Pachymetry: 529 µm · axial length 22.27 mm · man patient · intraocular pressure 12 mmHg.
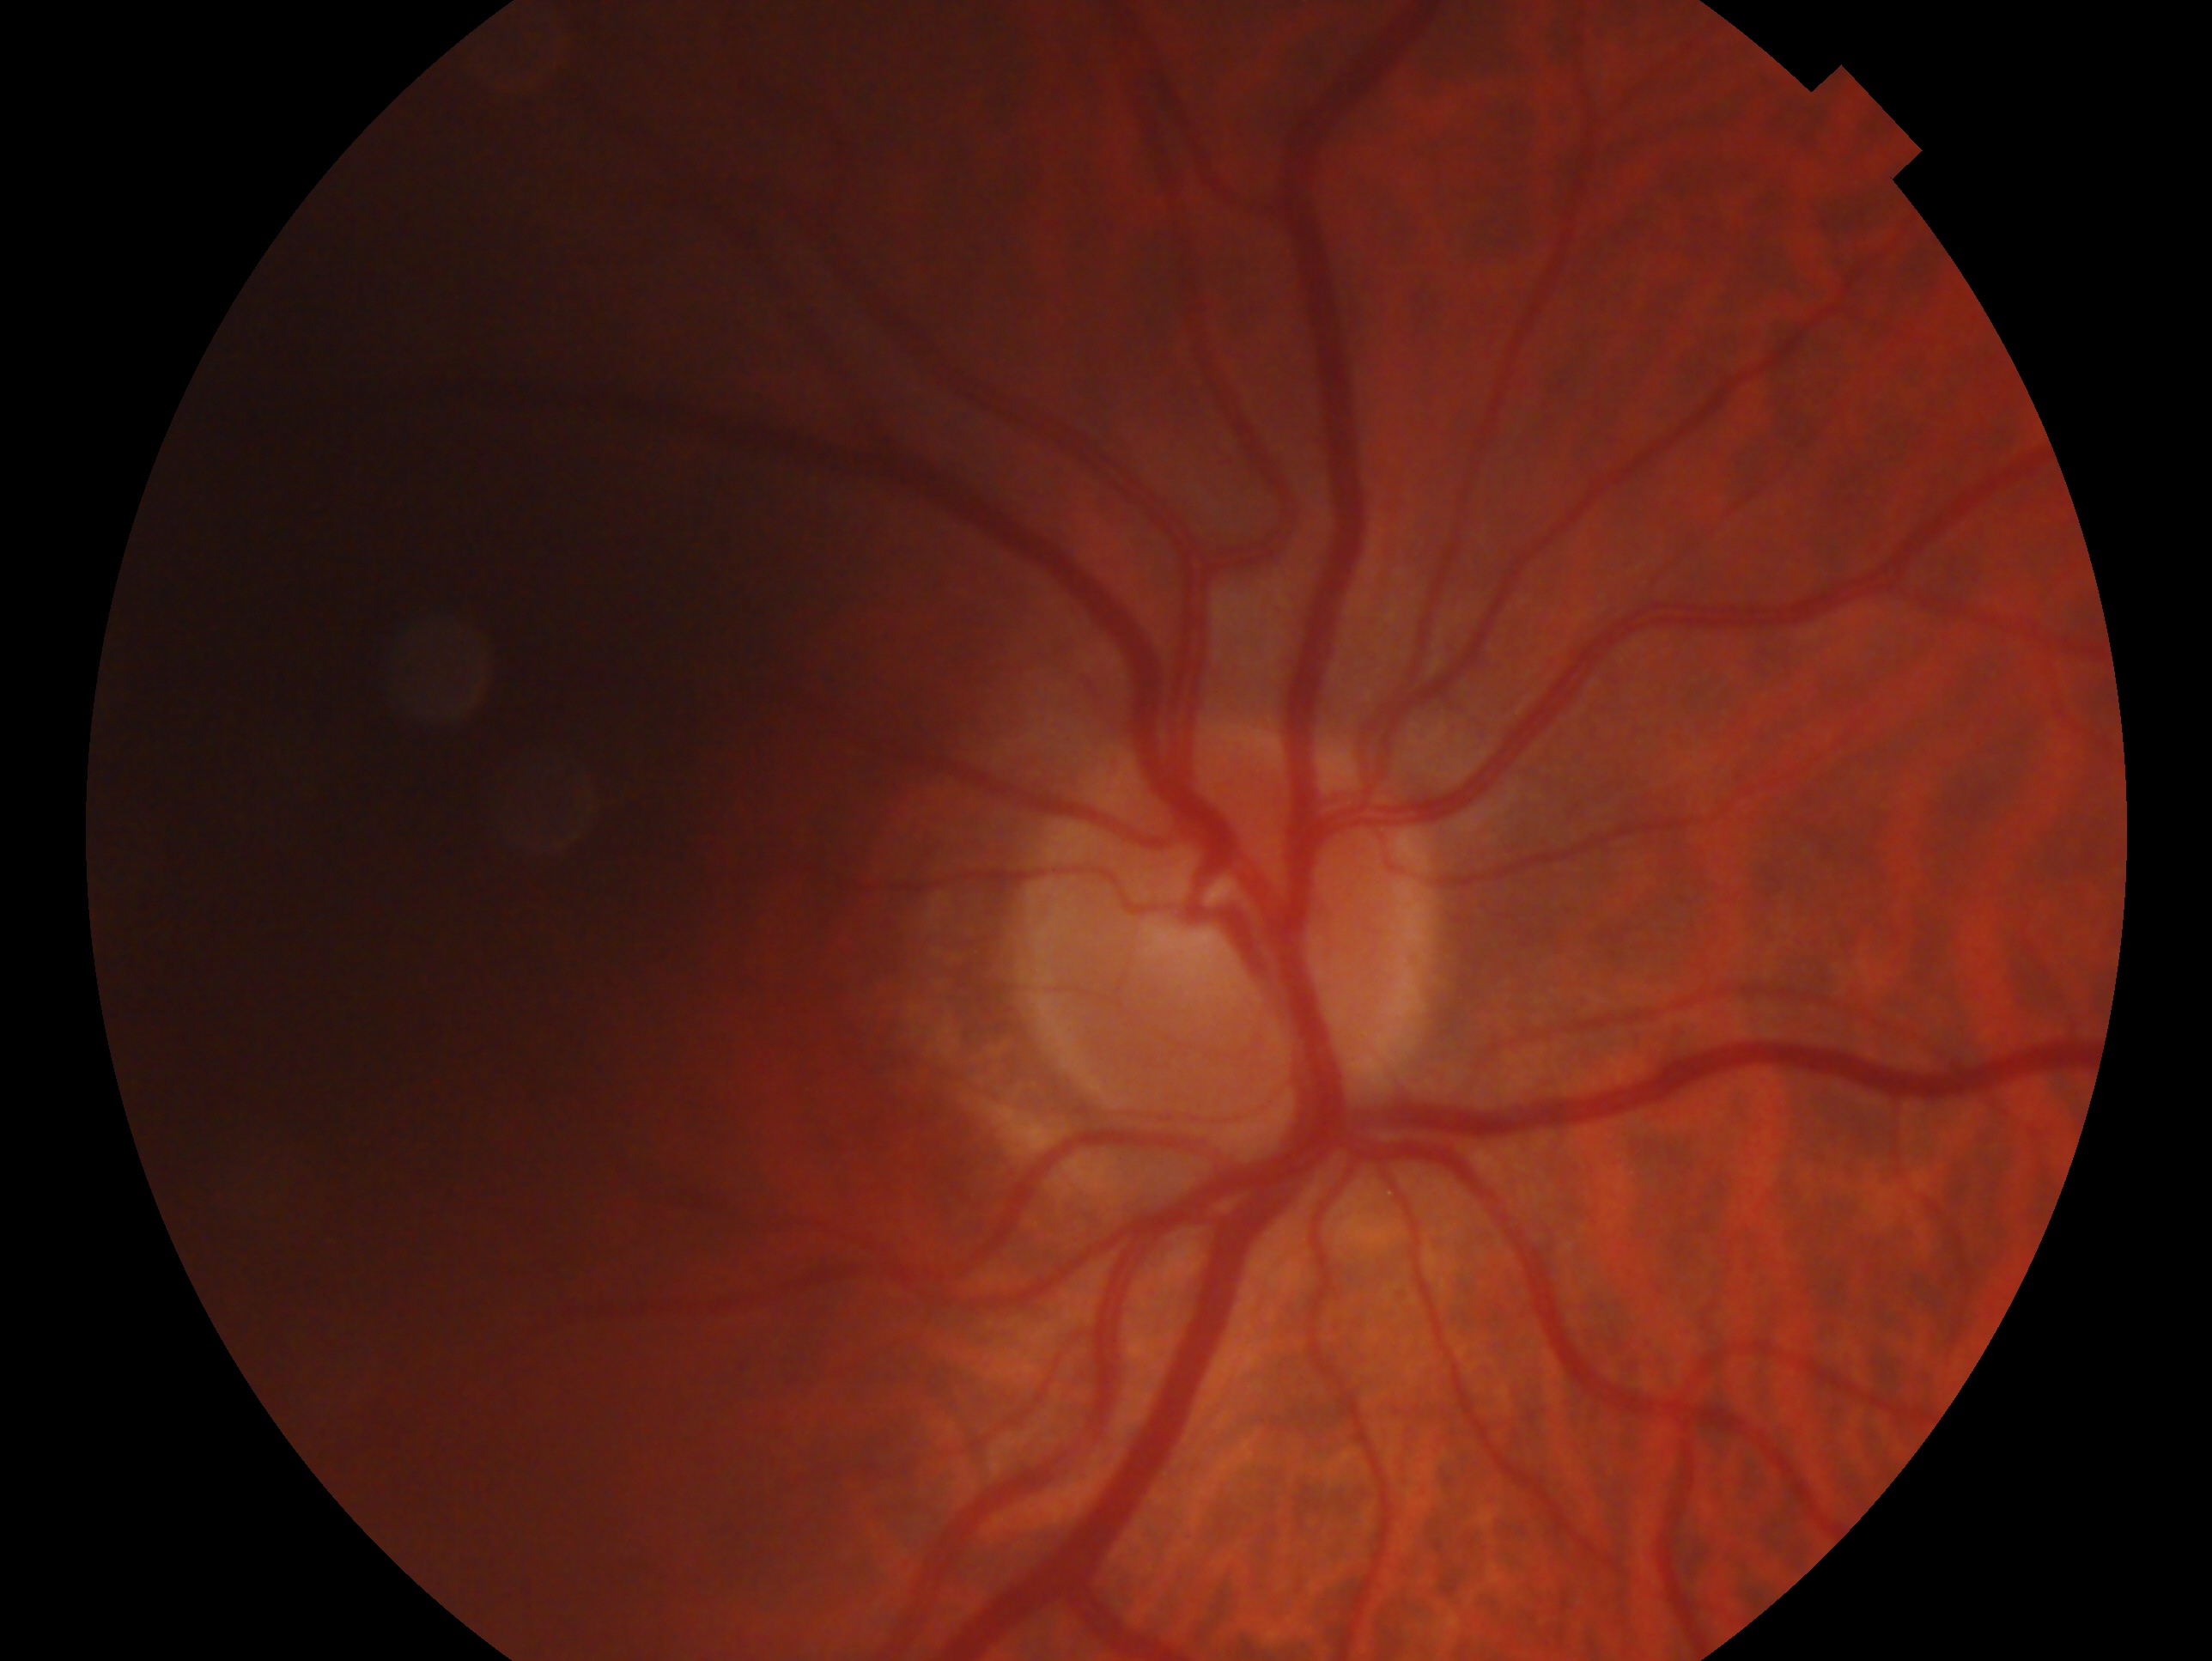
assessment: no evidence of glaucoma
laterality: right